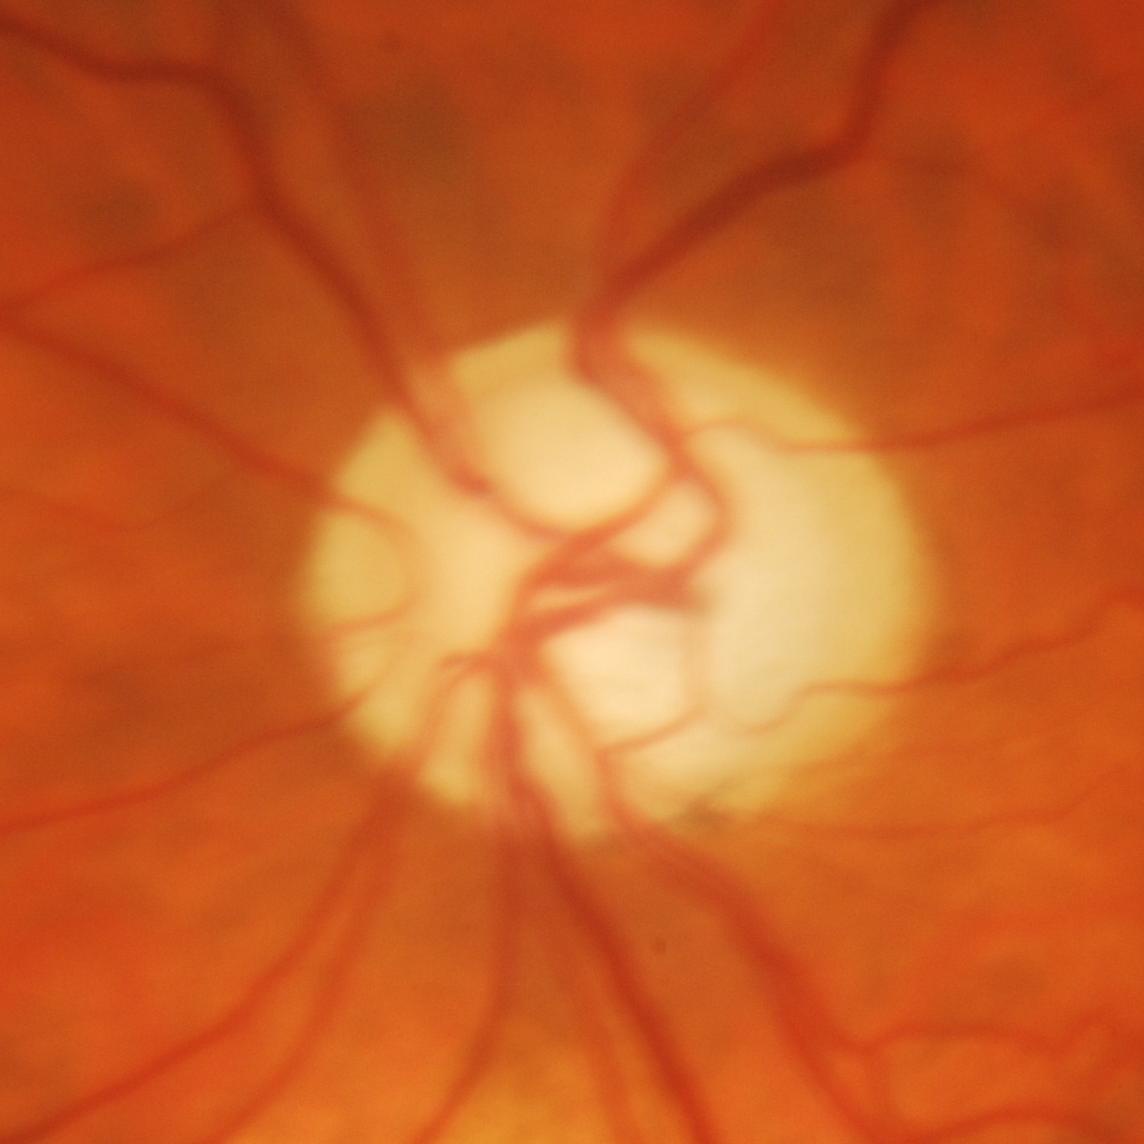
Q: Does this eye have glaucoma?
A: Yes — glaucoma.